Infant wide-field retinal image
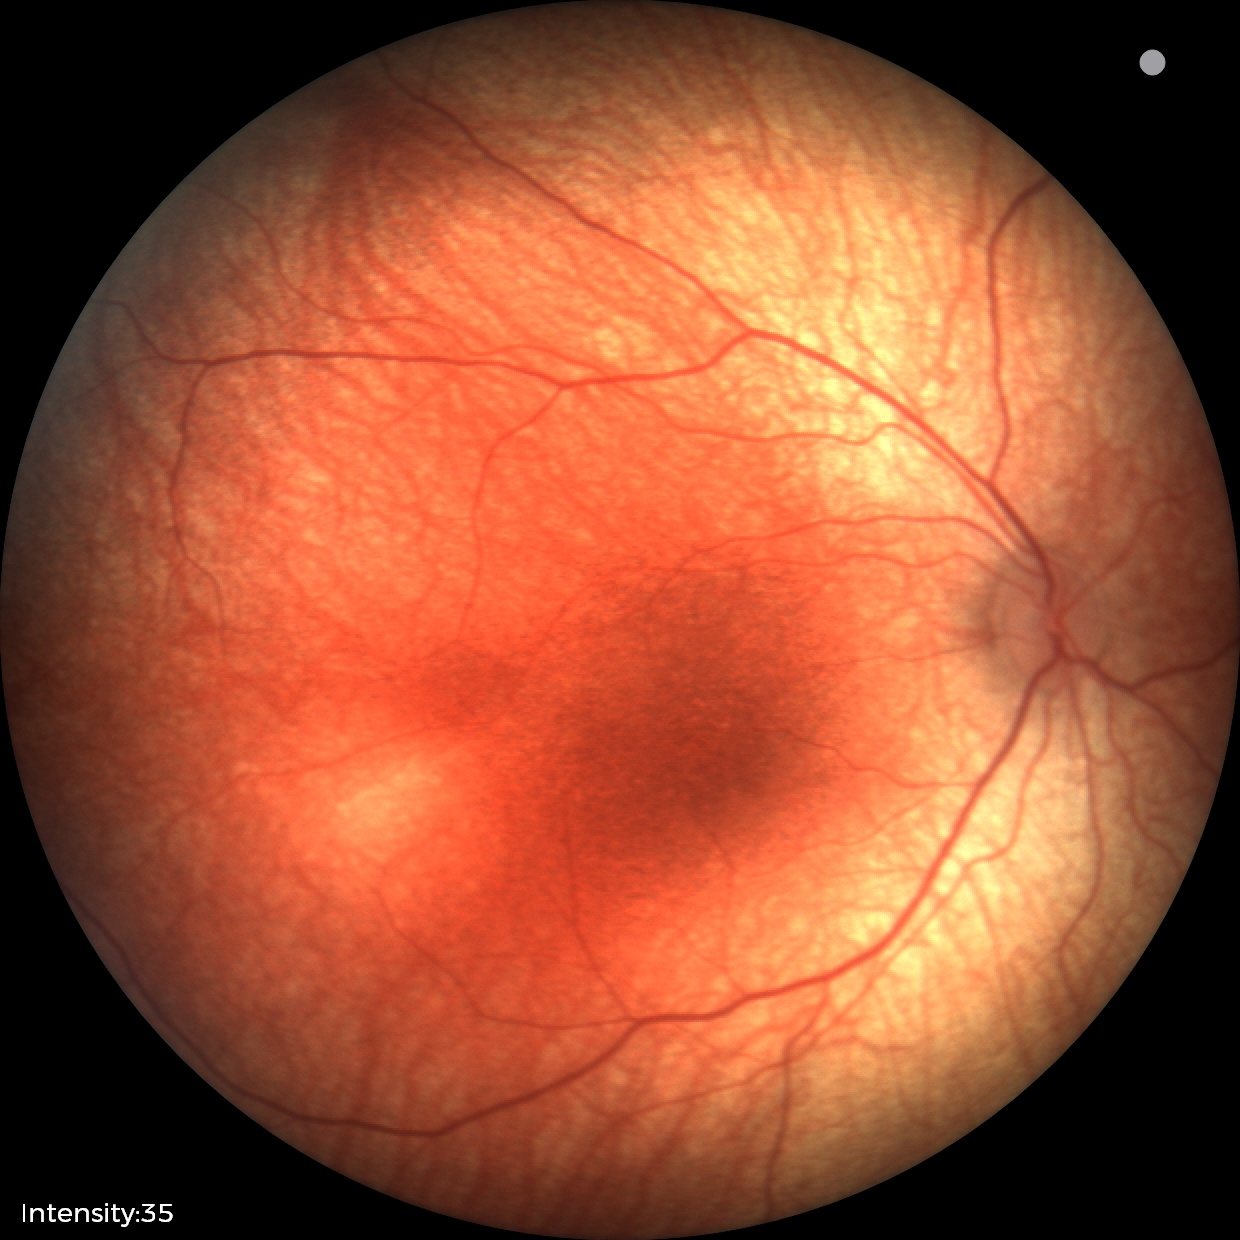

Screening examination diagnosed as physiological.